FOV: 45 degrees, NIDEK AFC-230.
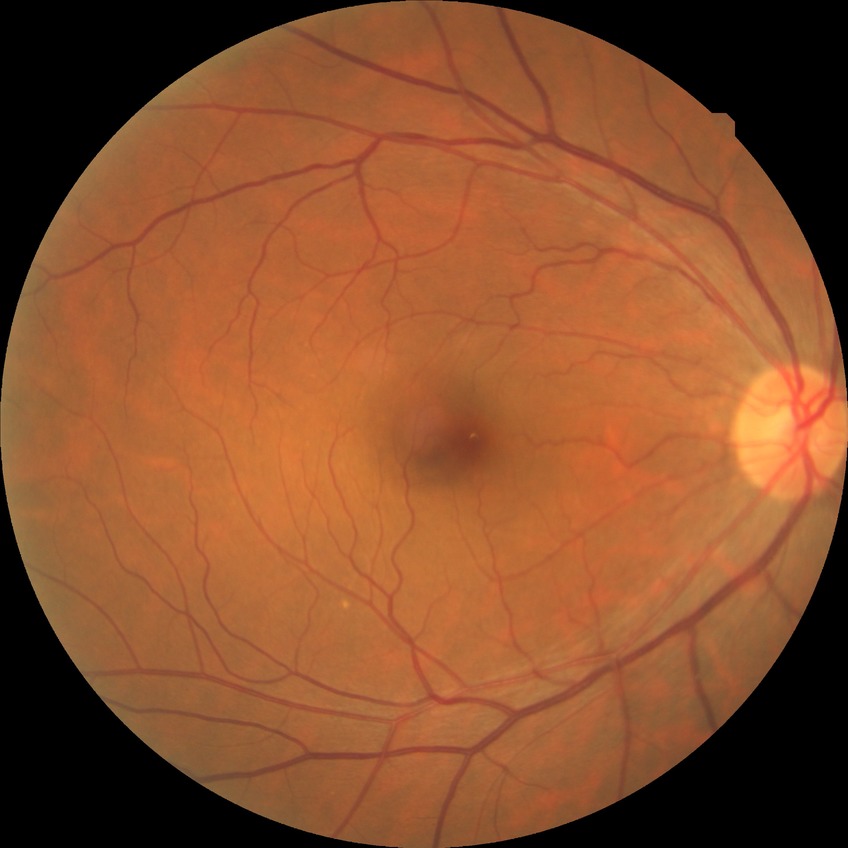
{"dr_impression": "no signs of DR", "davis_grade": "NDR"}